Camera: Clarity RetCam 3 (130° FOV). Infant wide-field retinal image. 640 x 480 pixels.
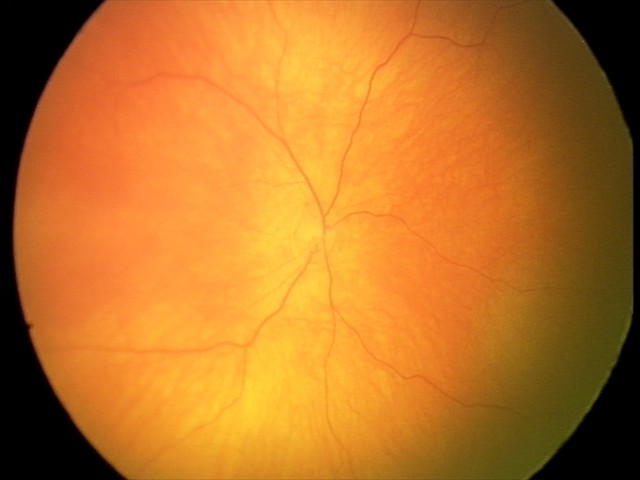

Assessment: normal retinal appearance.